45° field of view
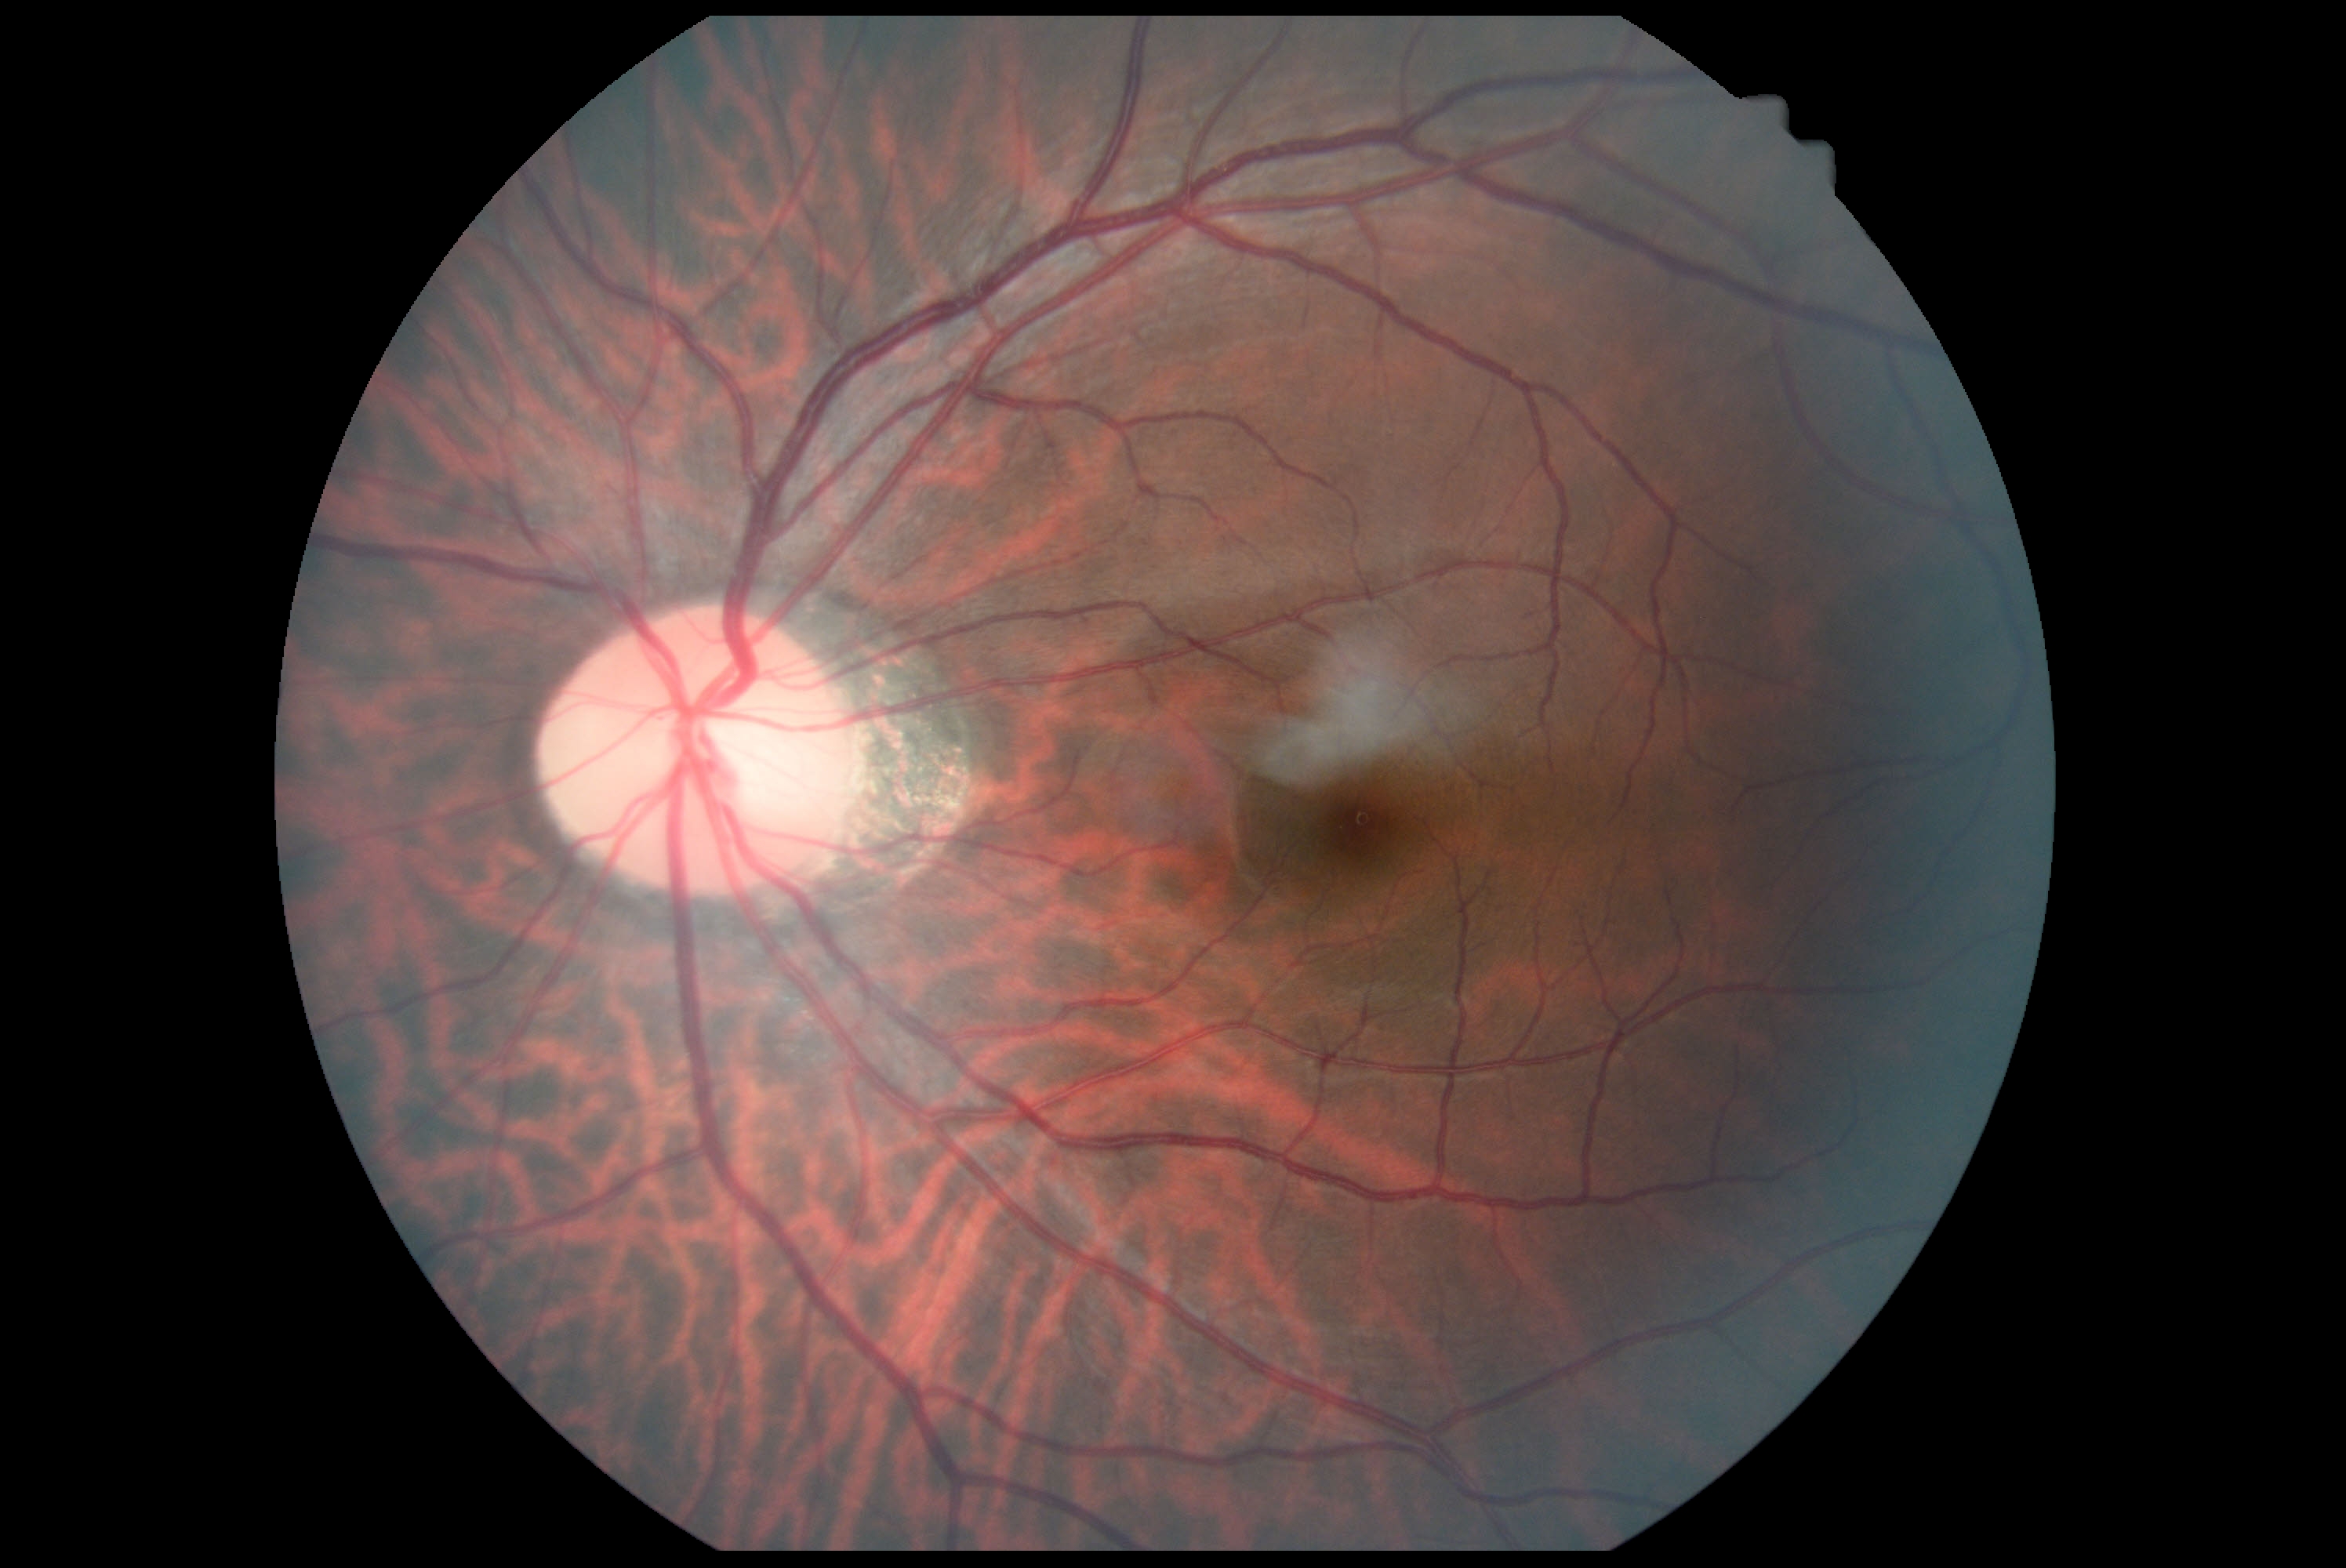
Diabetic retinopathy (DR): grade 0 — no visible signs of diabetic retinopathy.